2361x1568. Retinal fundus photograph — 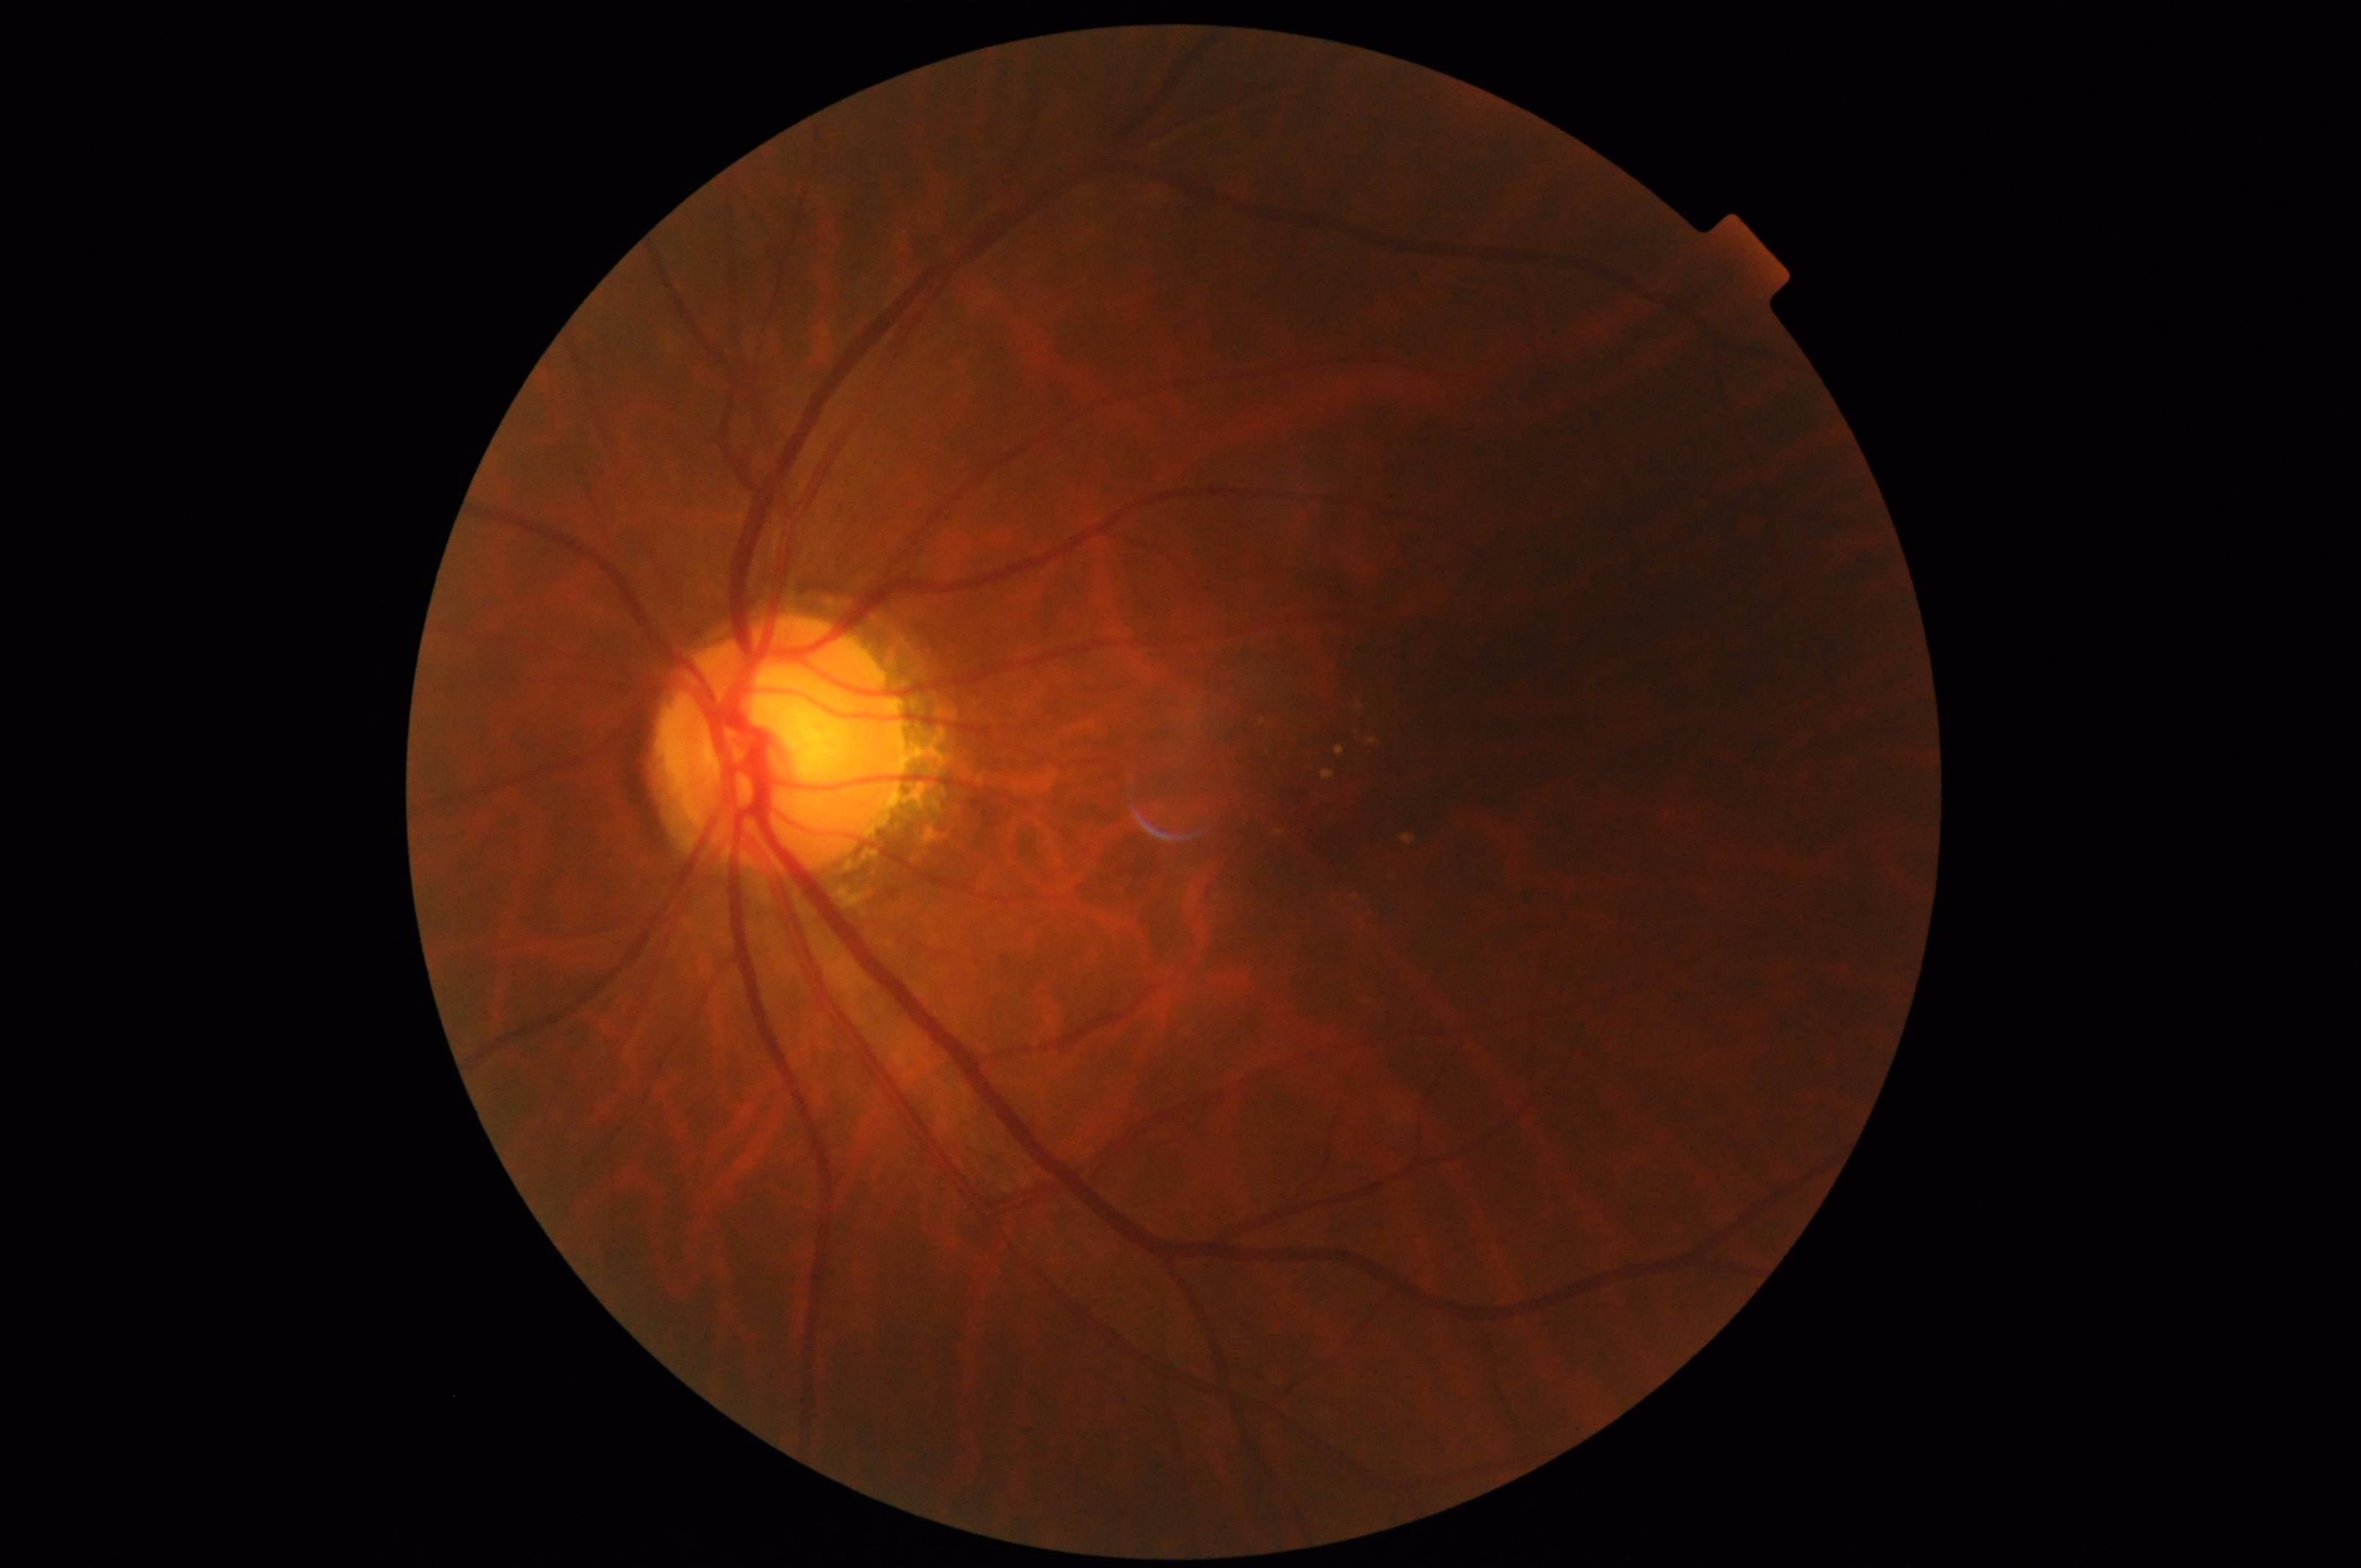
Vessels and details are readily distinguishable. Illumination and color are suboptimal.